Wide-field fundus photograph from neonatal ROP screening — 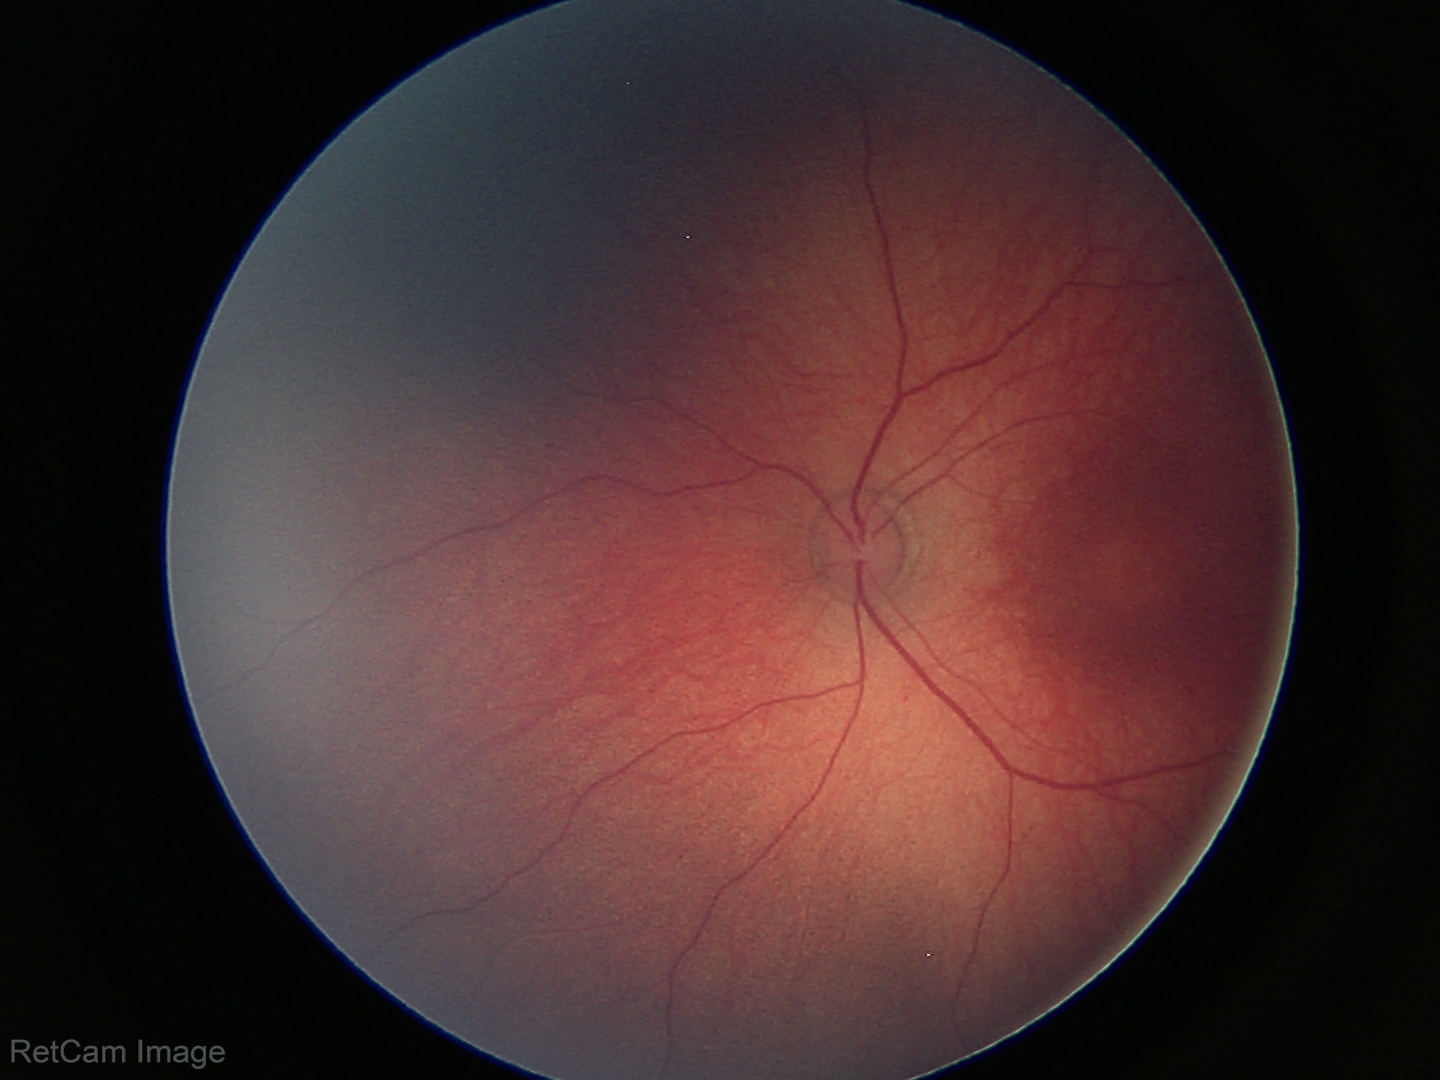

Physiological retinal appearance for postconceptual age.